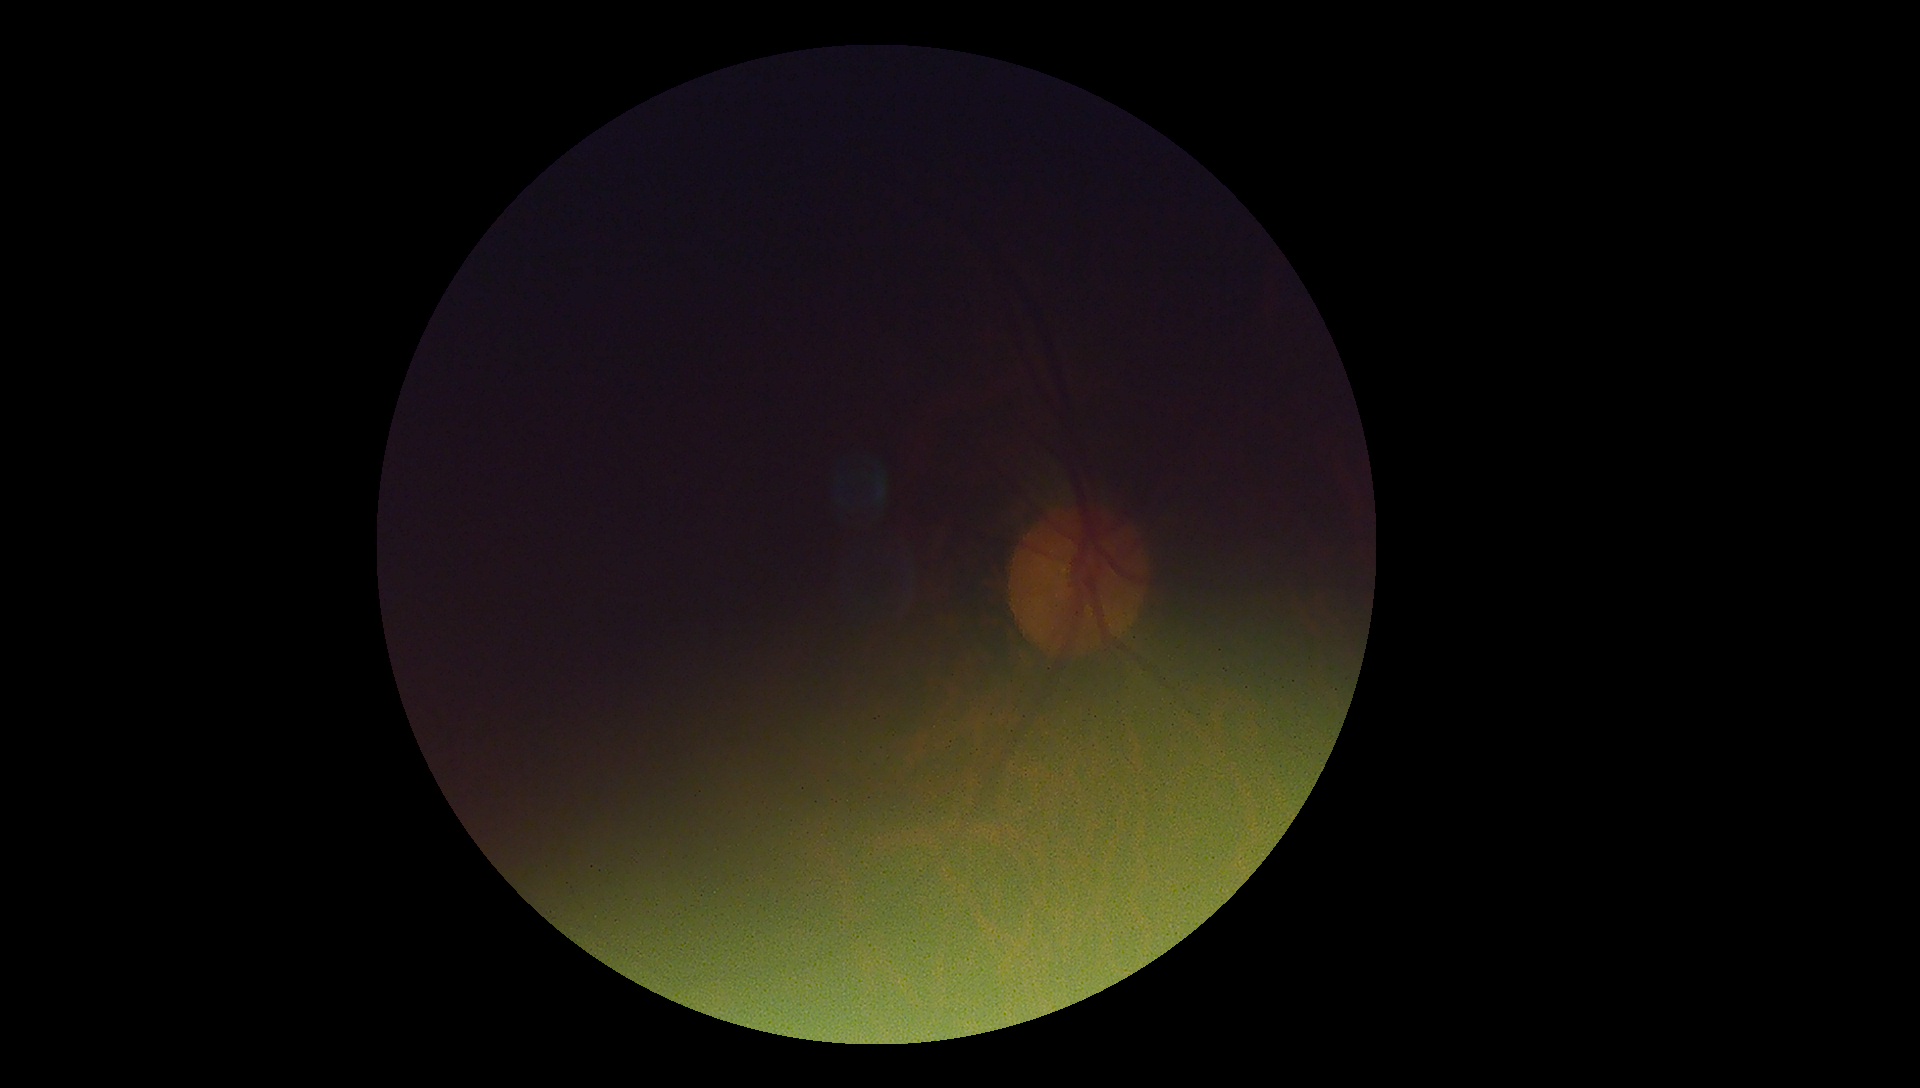

Ungradable image — DR severity cannot be determined.
DR stage is ungradable due to poor image quality.